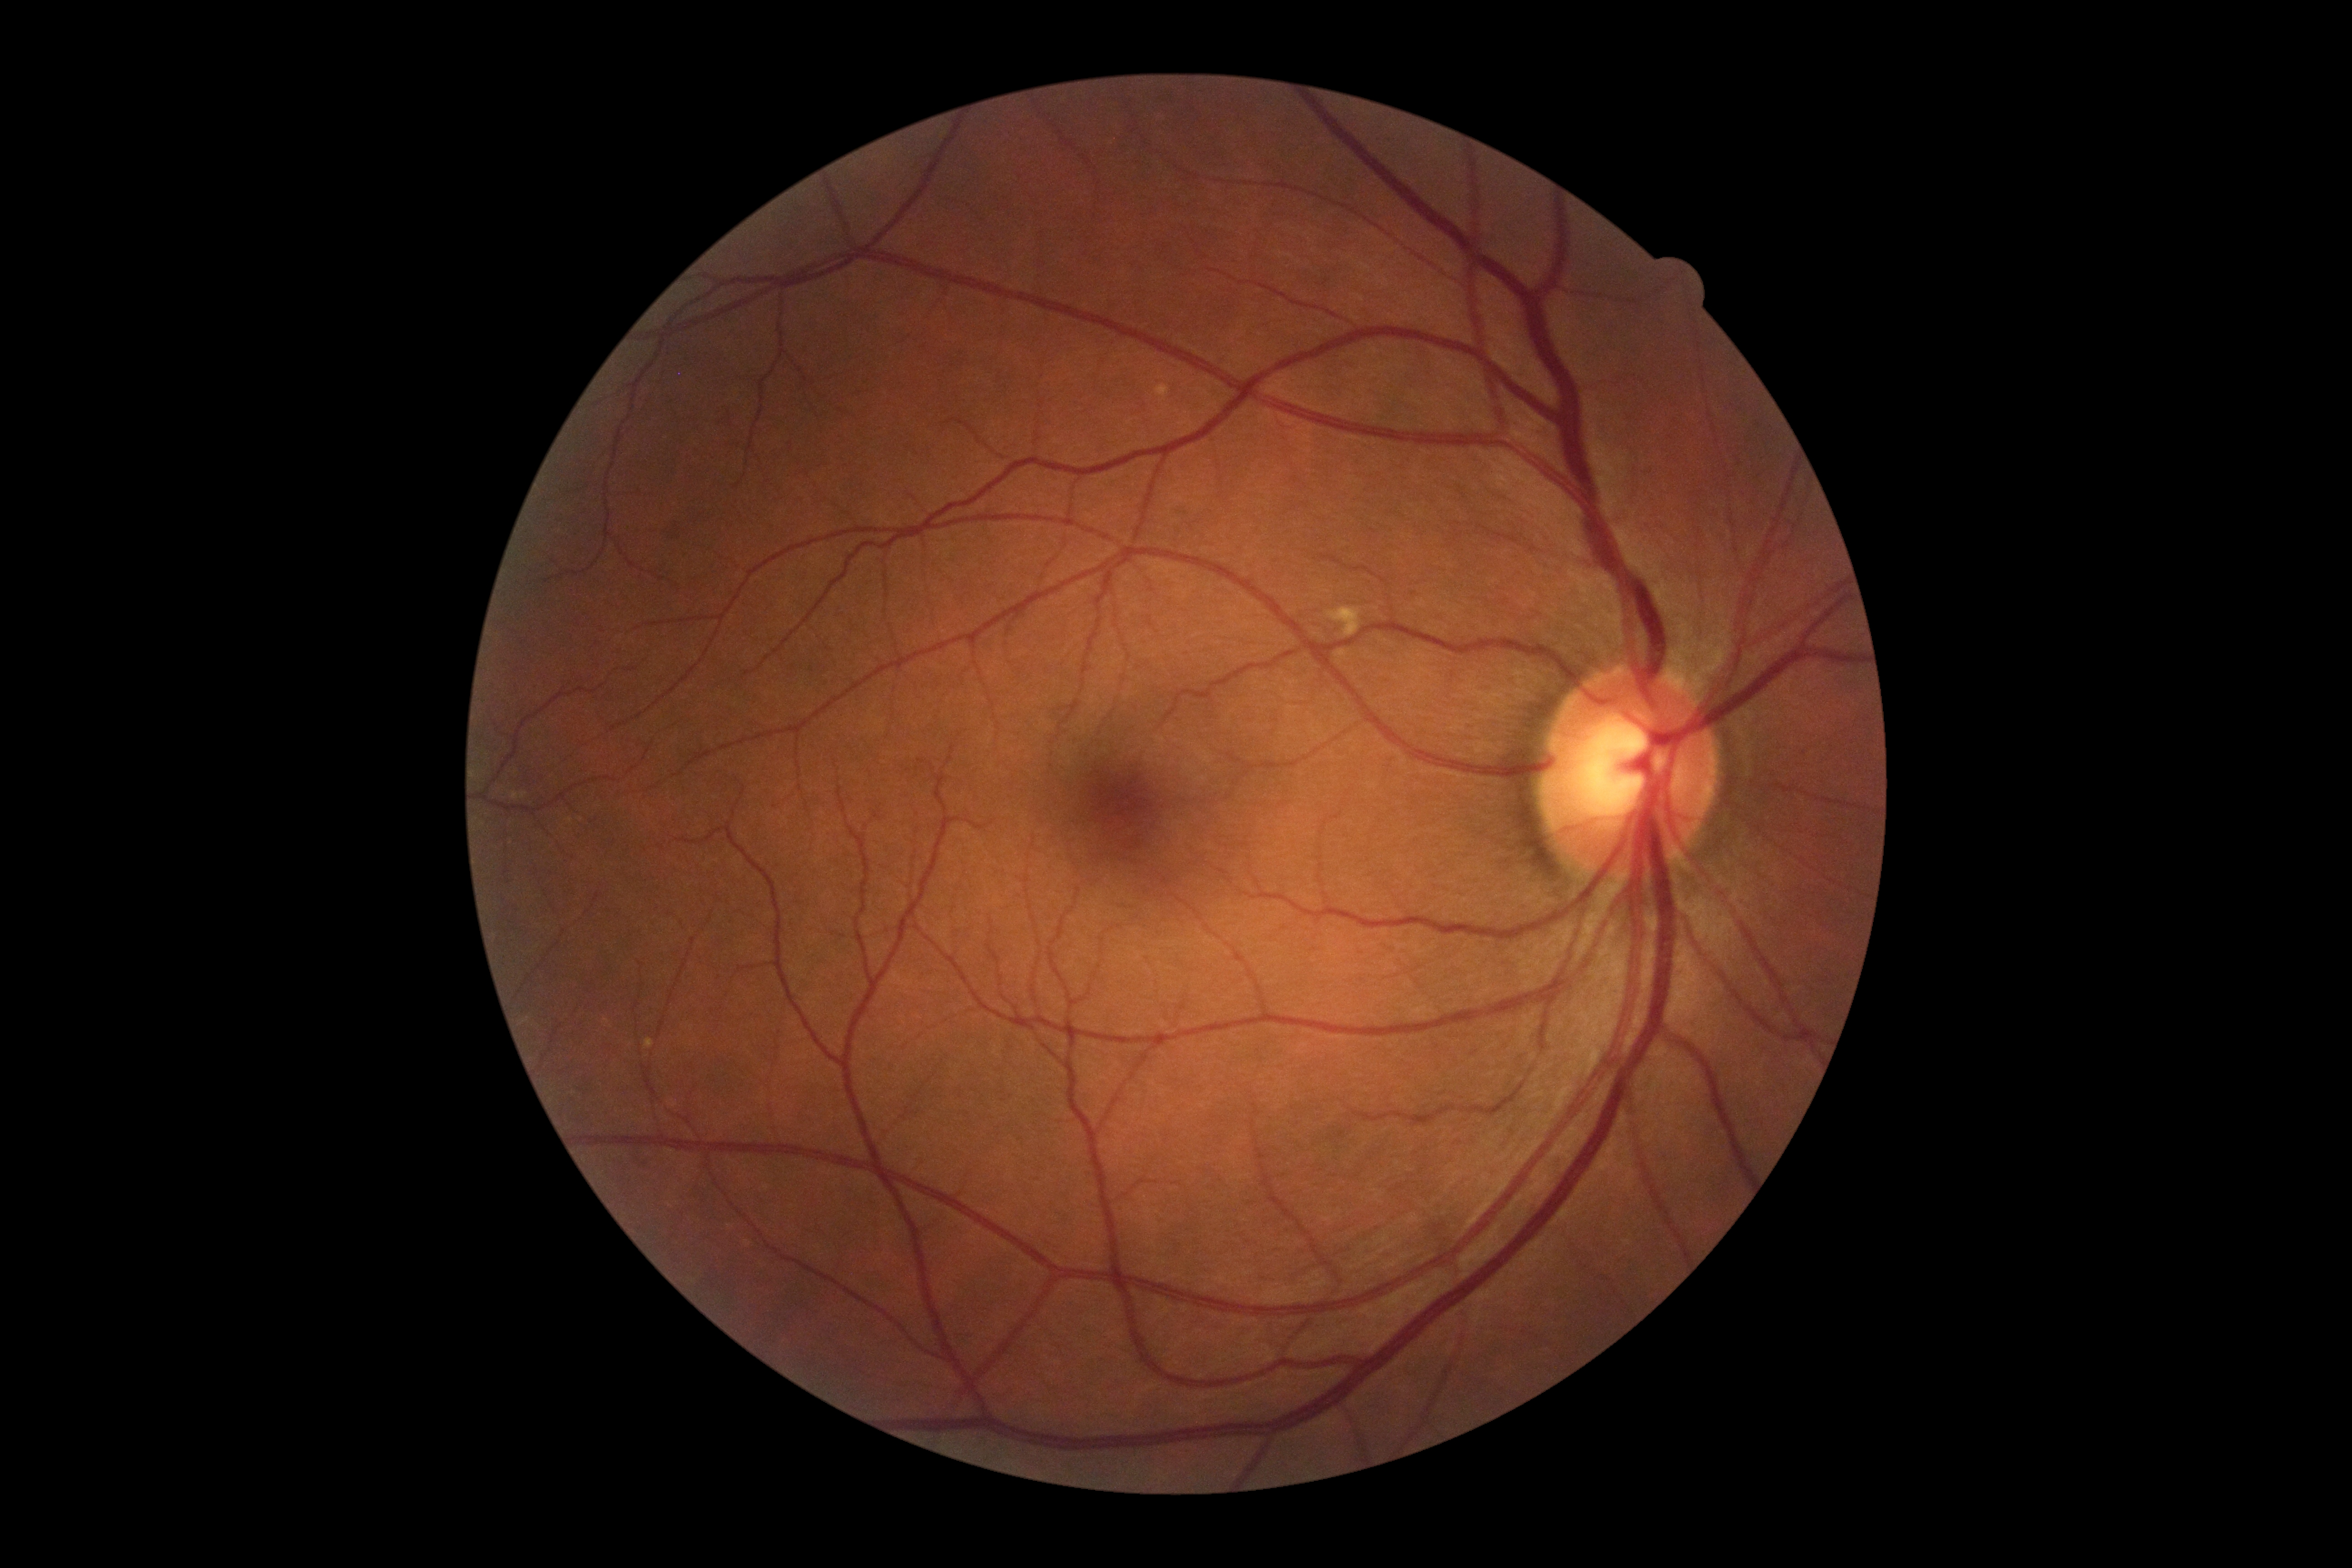

DR grade is 0.